Captured with the Clarity RetCam 3 (130° field of view) · 640x480 · pediatric retinal photograph (wide-field)
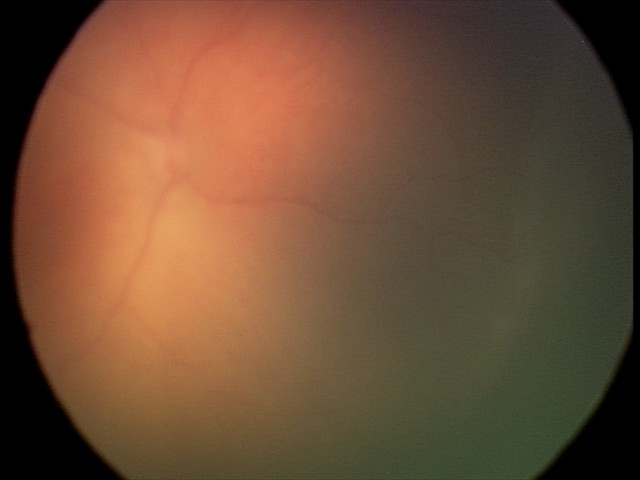 Screening series with retinopathy of prematurity stage 1.